CFP:
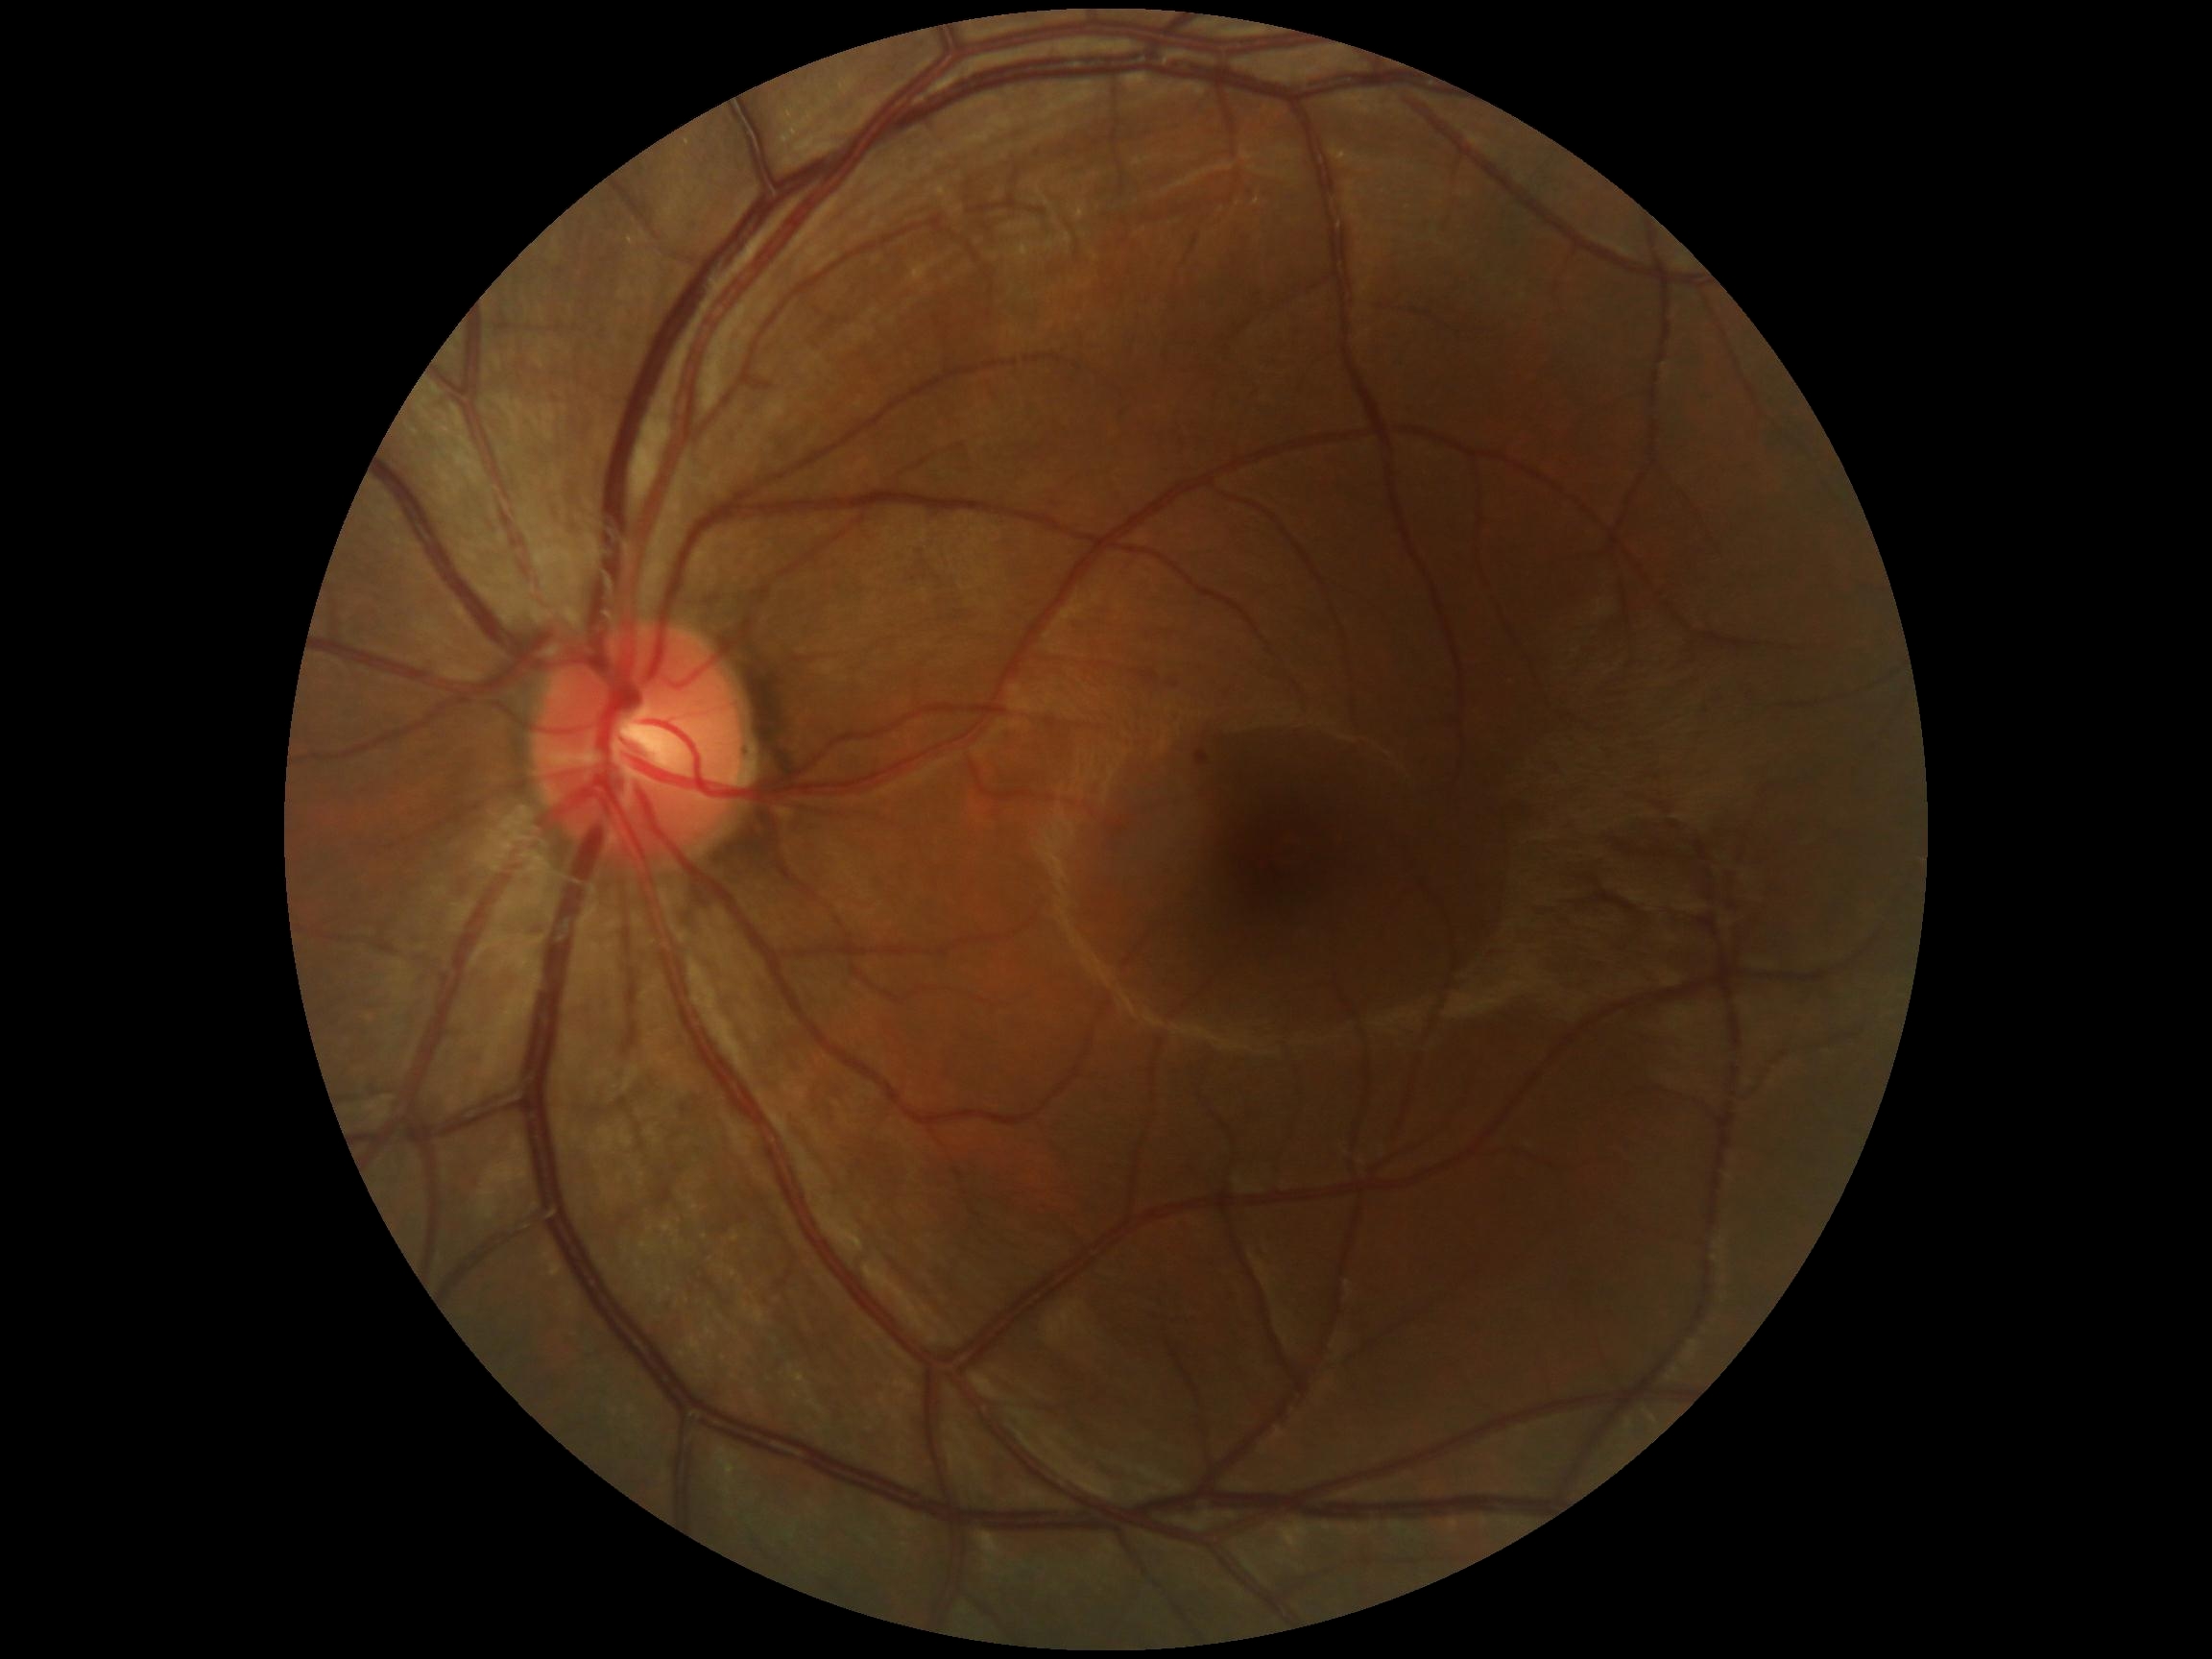
dr_grade: 1/4